1440x1080px; RetCam wide-field infant fundus image
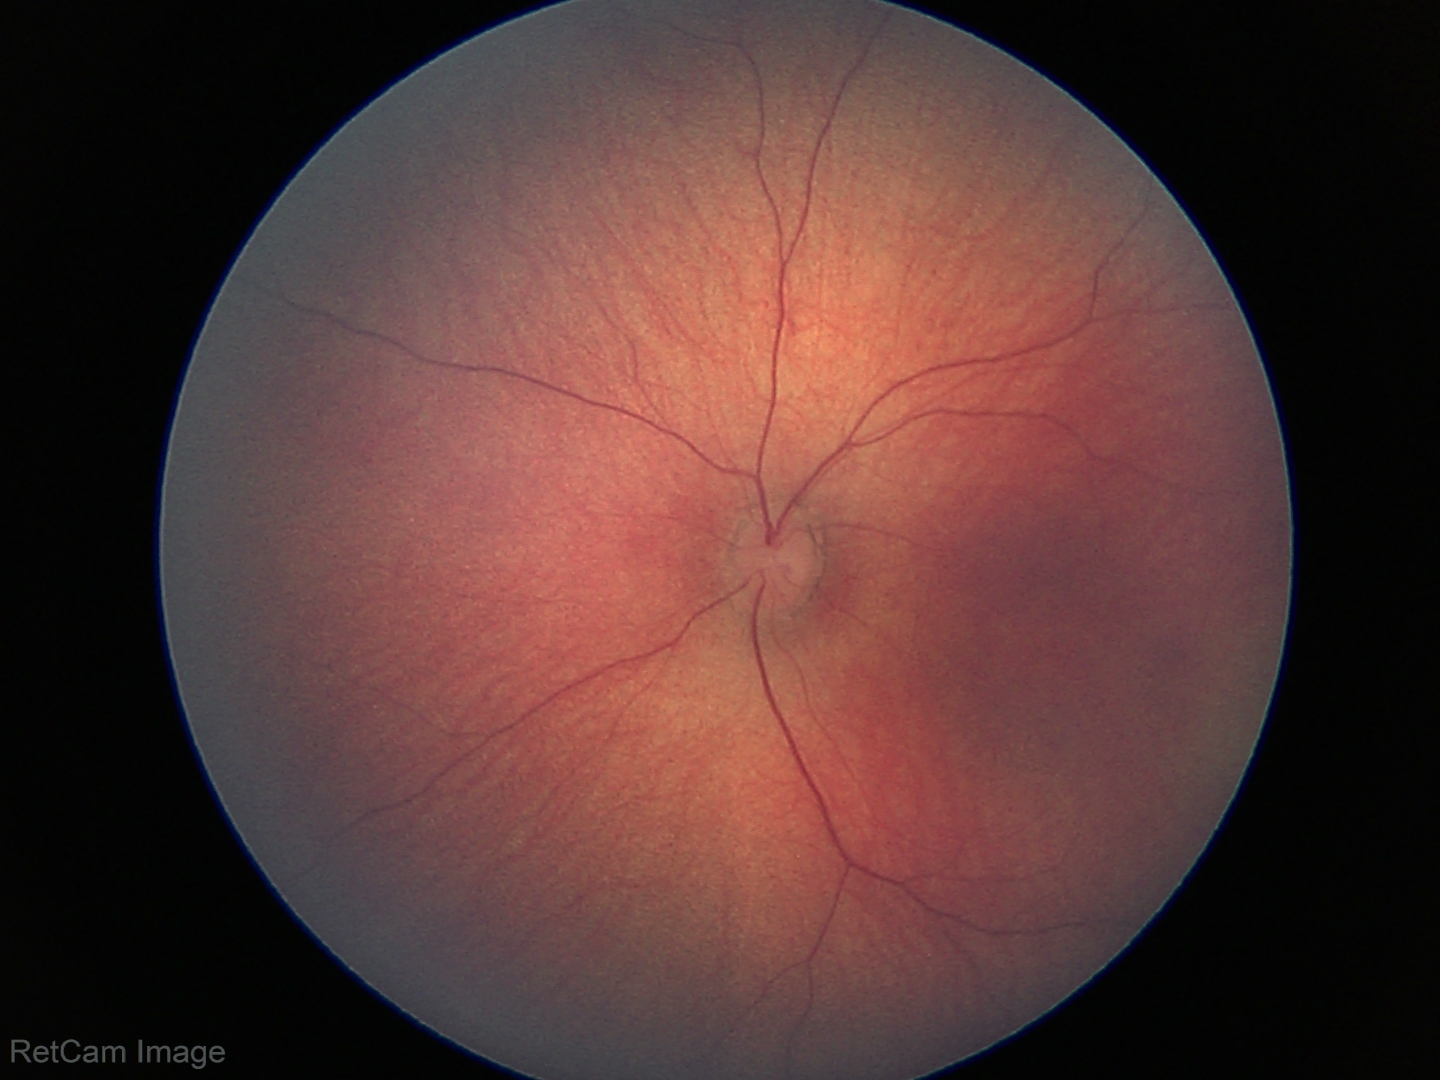
Screening examination diagnosed as physiological.